45° FOV. 1920 by 1088 pixels. CFP.
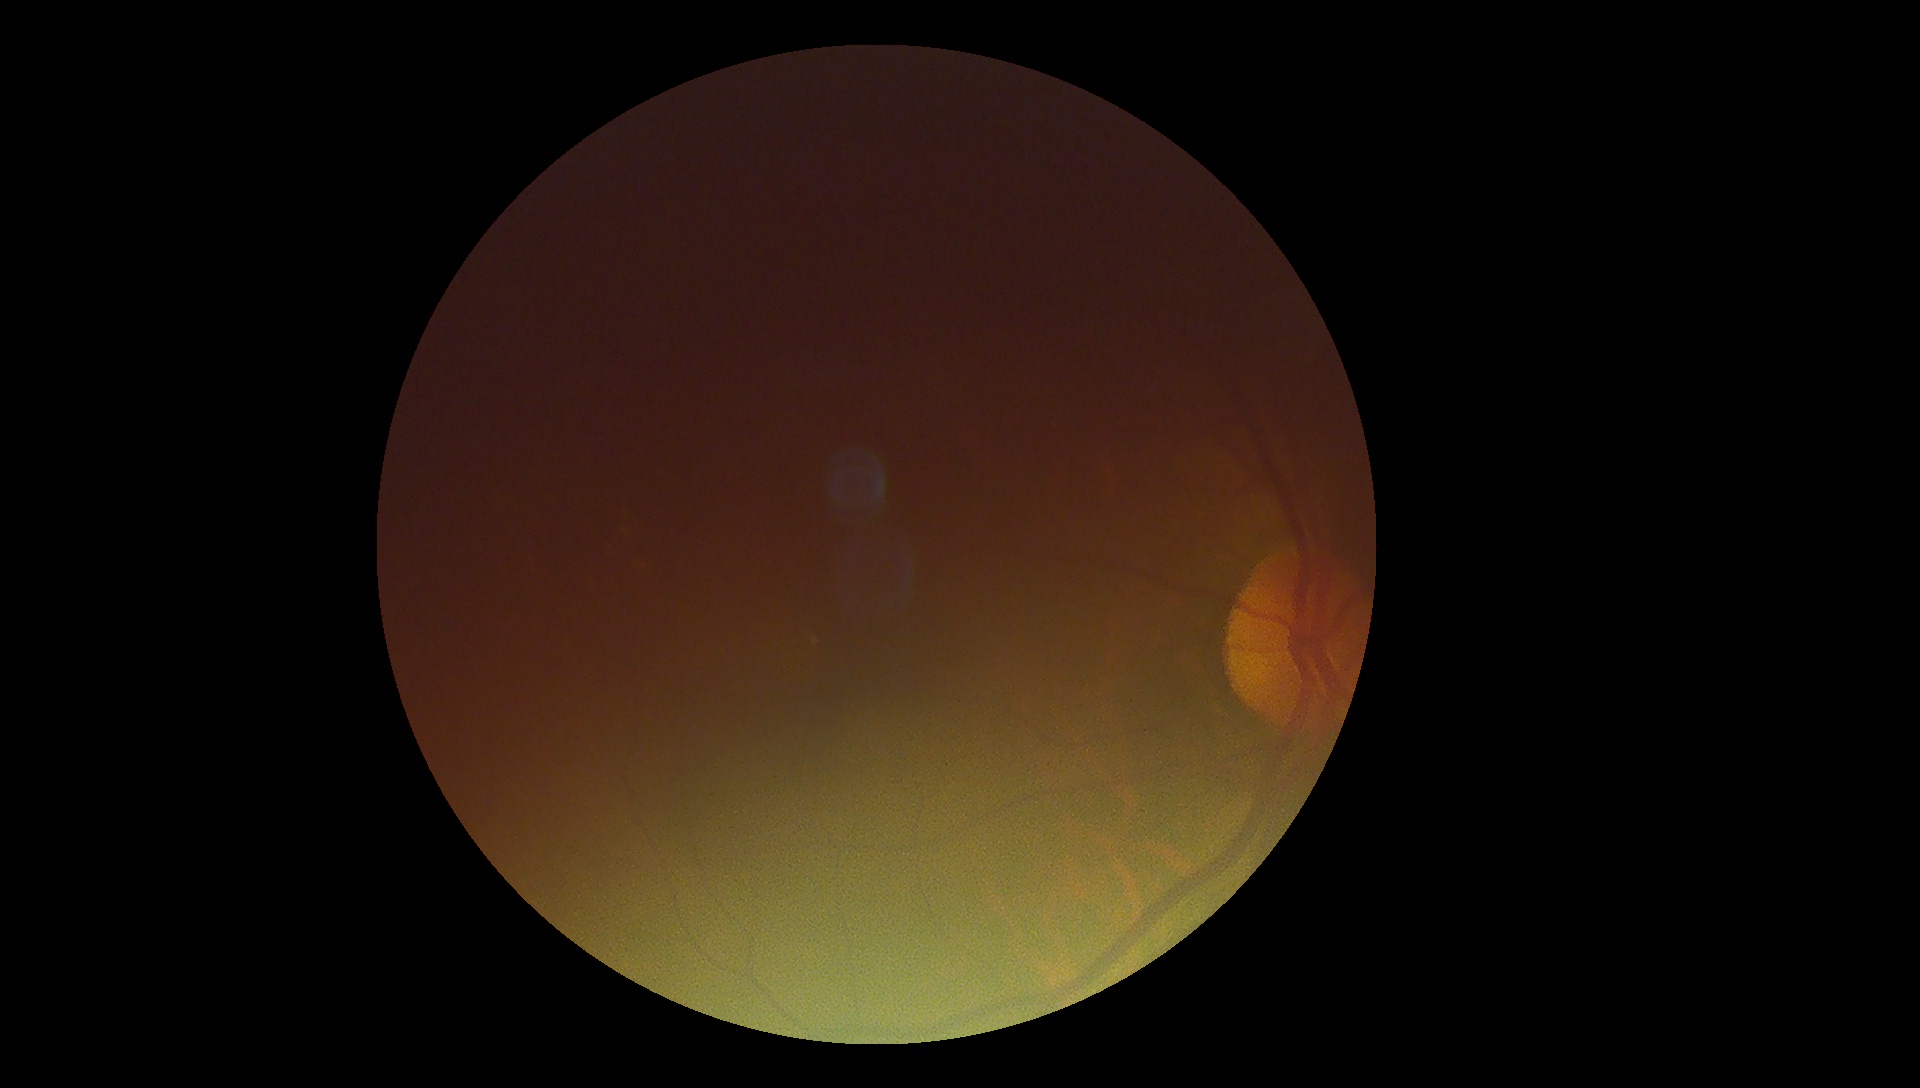

DR = ungradable.